CFP; 2352x1568; FOV: 45 degrees: 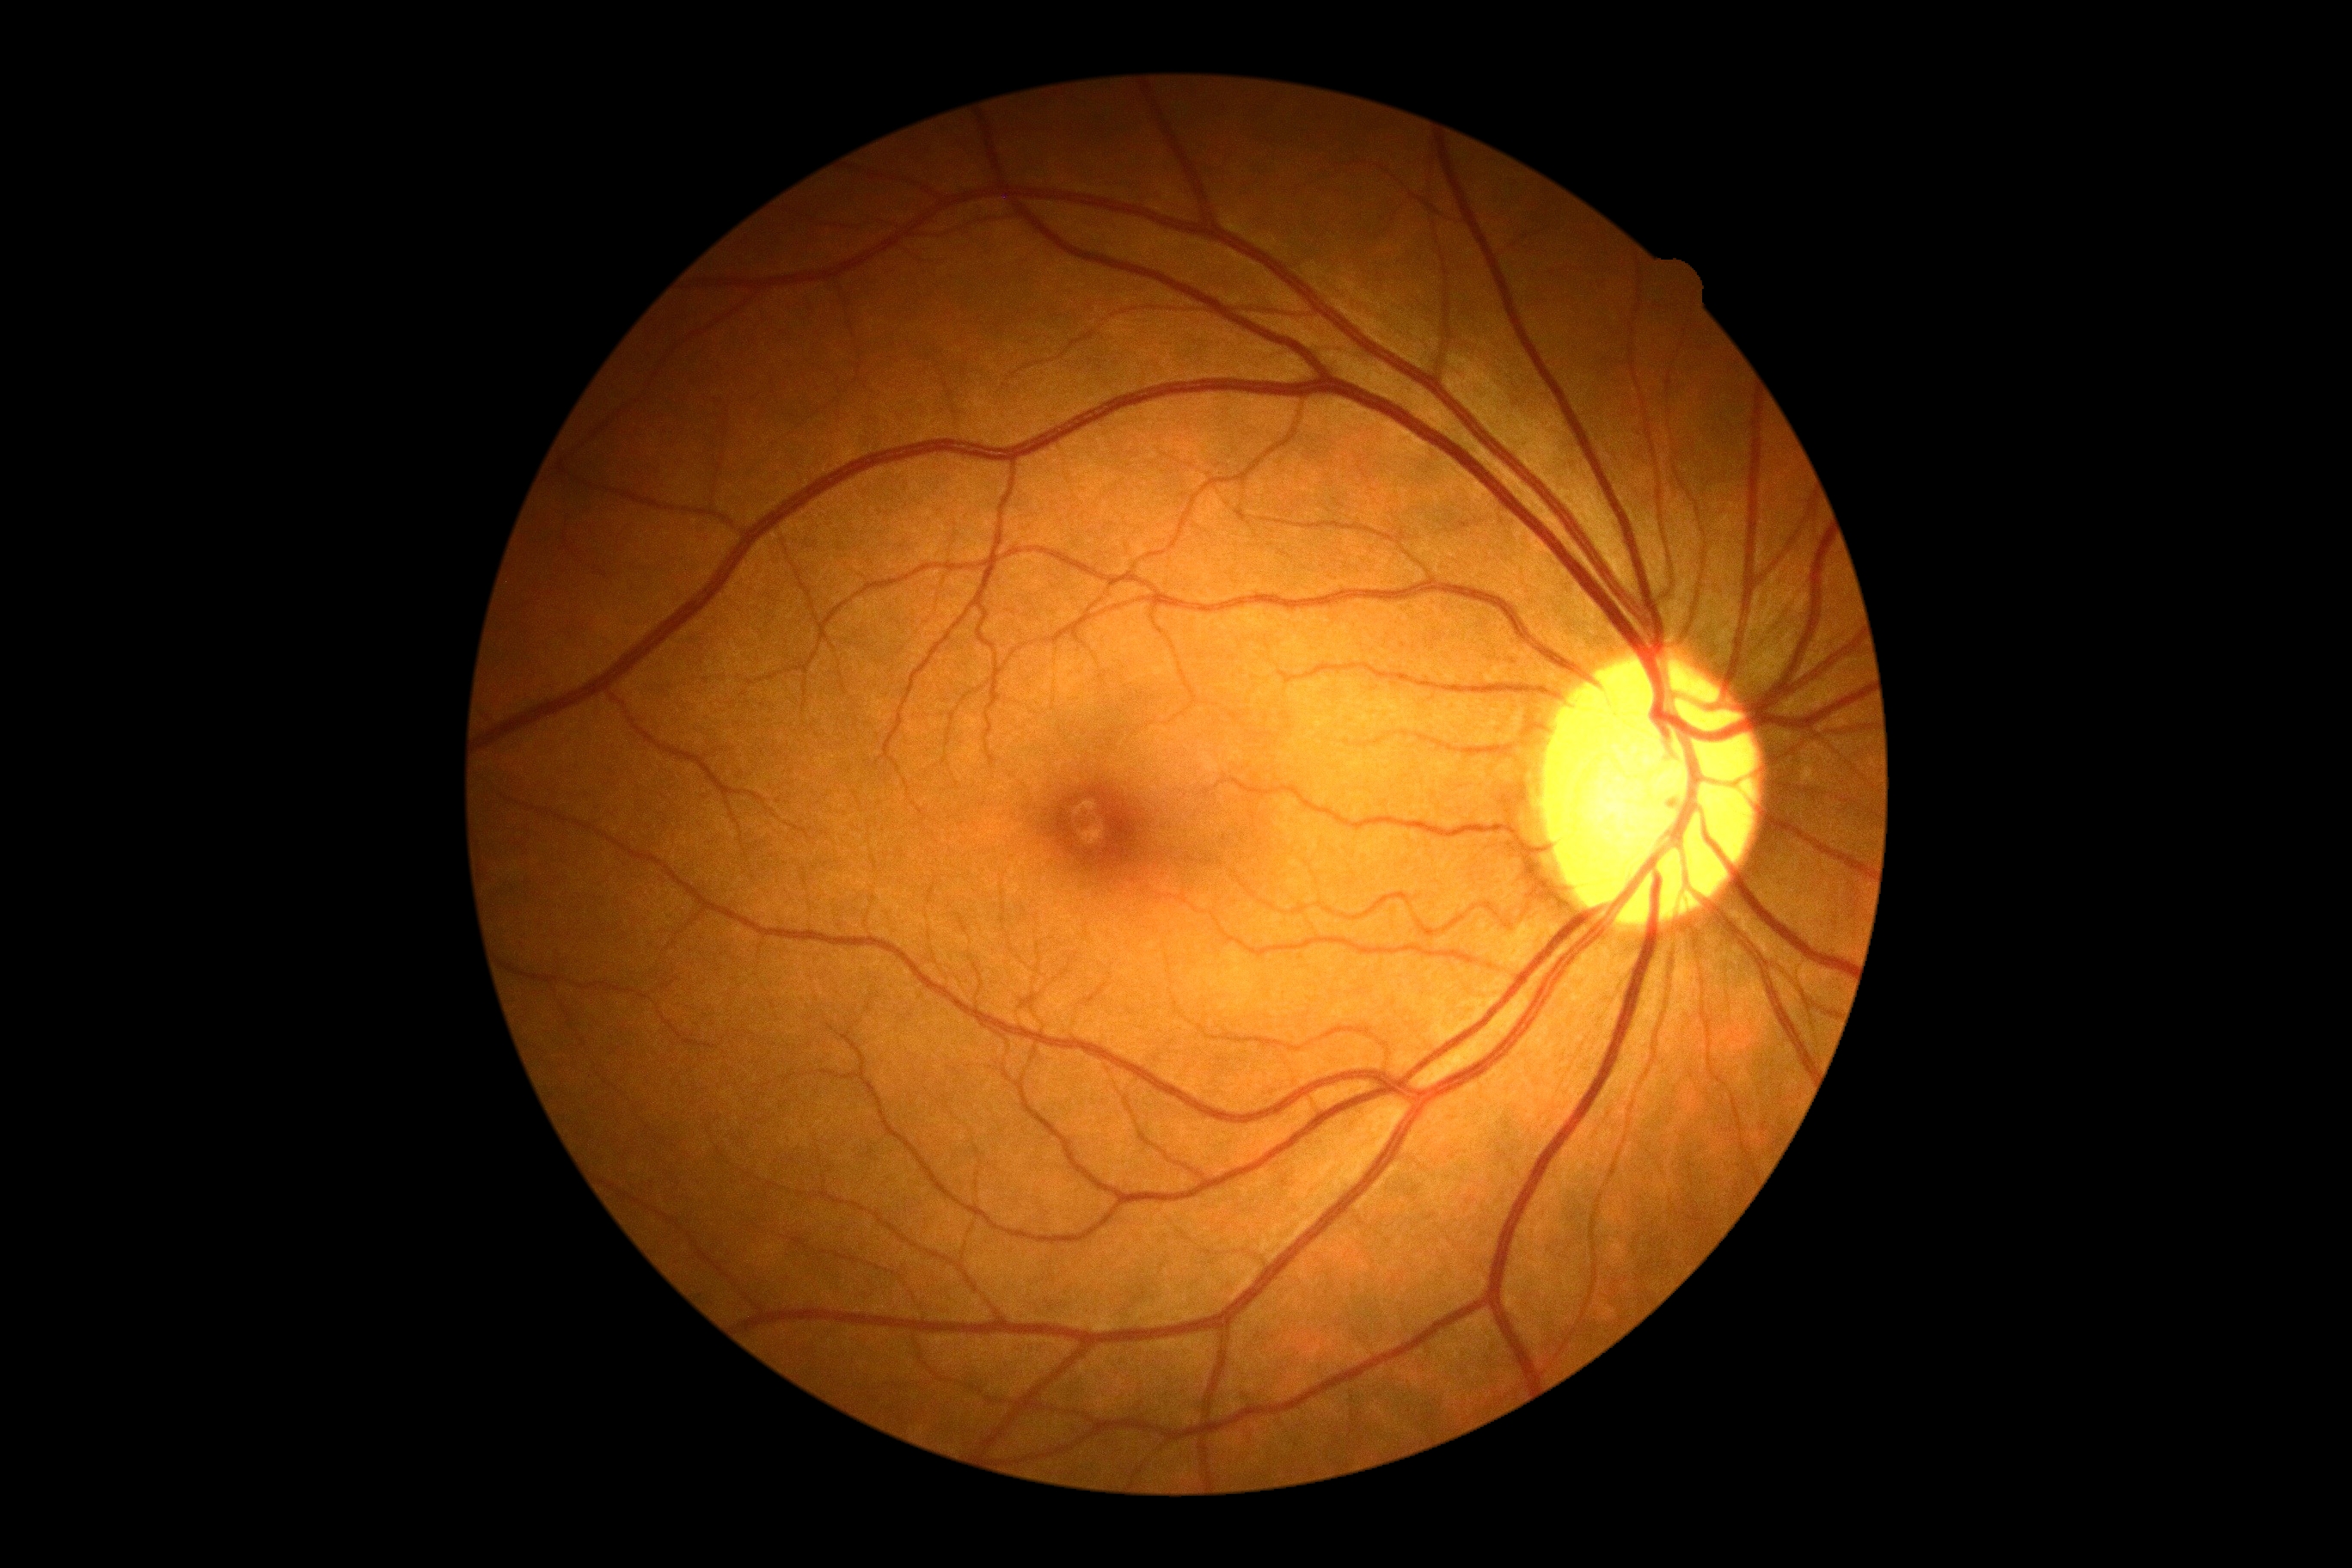
Diabetic retinopathy (DR): no apparent diabetic retinopathy (grade 0).
No apparent diabetic retinopathy.